1440x1080. Infant wide-field retinal image.
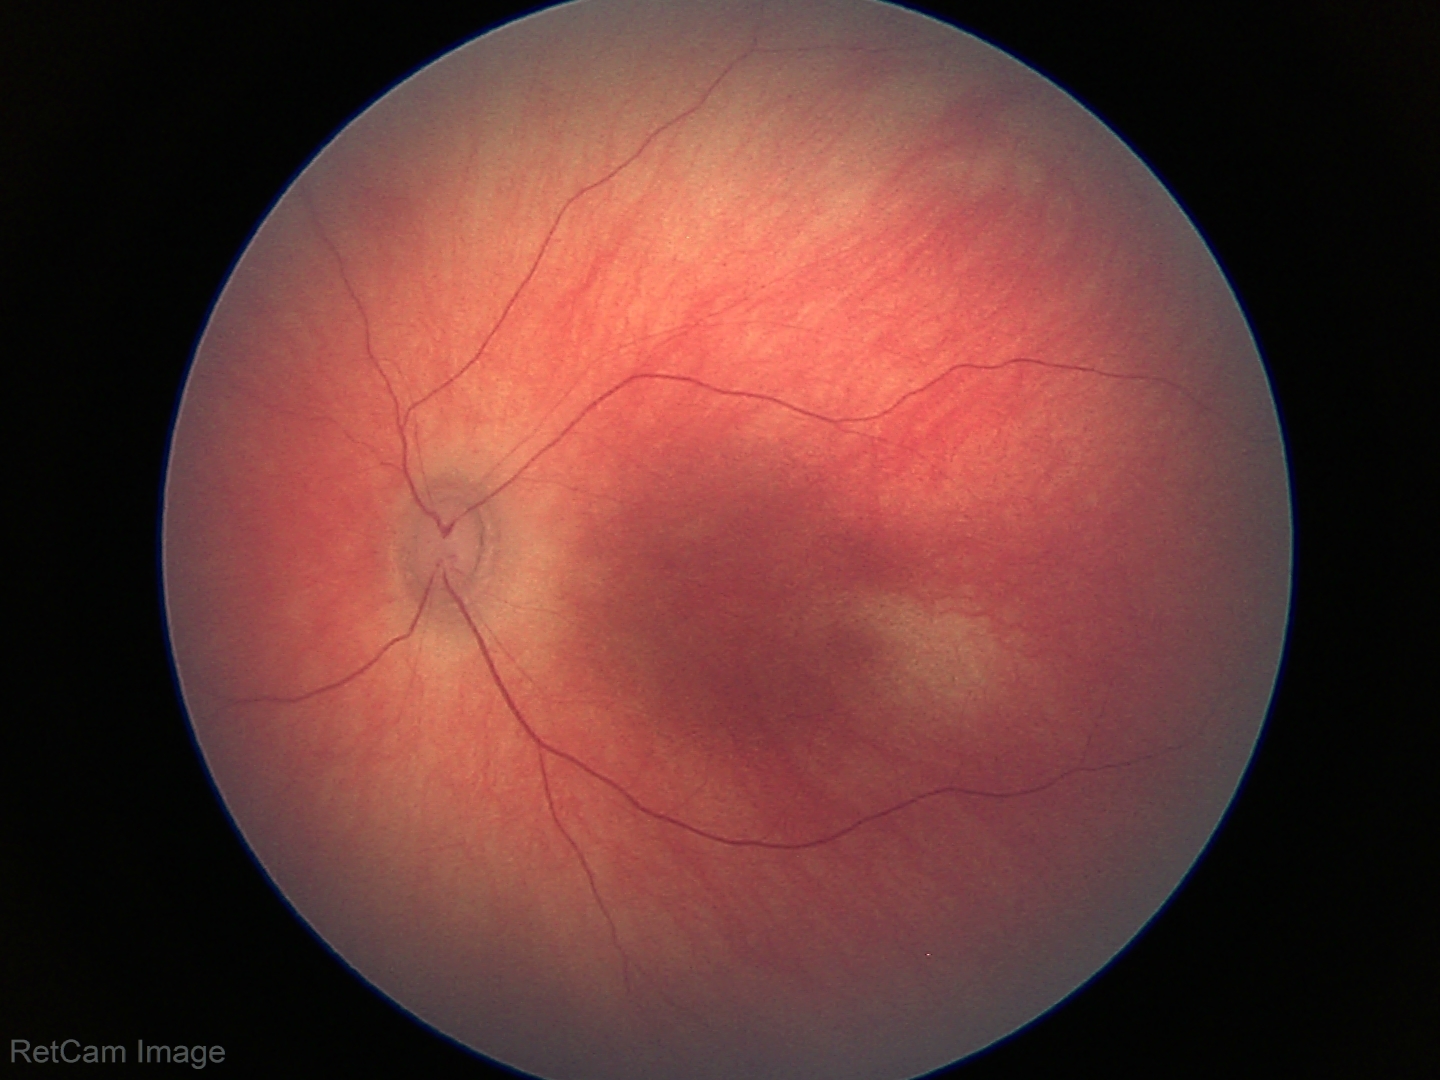 Screening: normal retinal appearance.